FOV: 45 degrees; 1725 by 1721 pixels; color fundus photograph
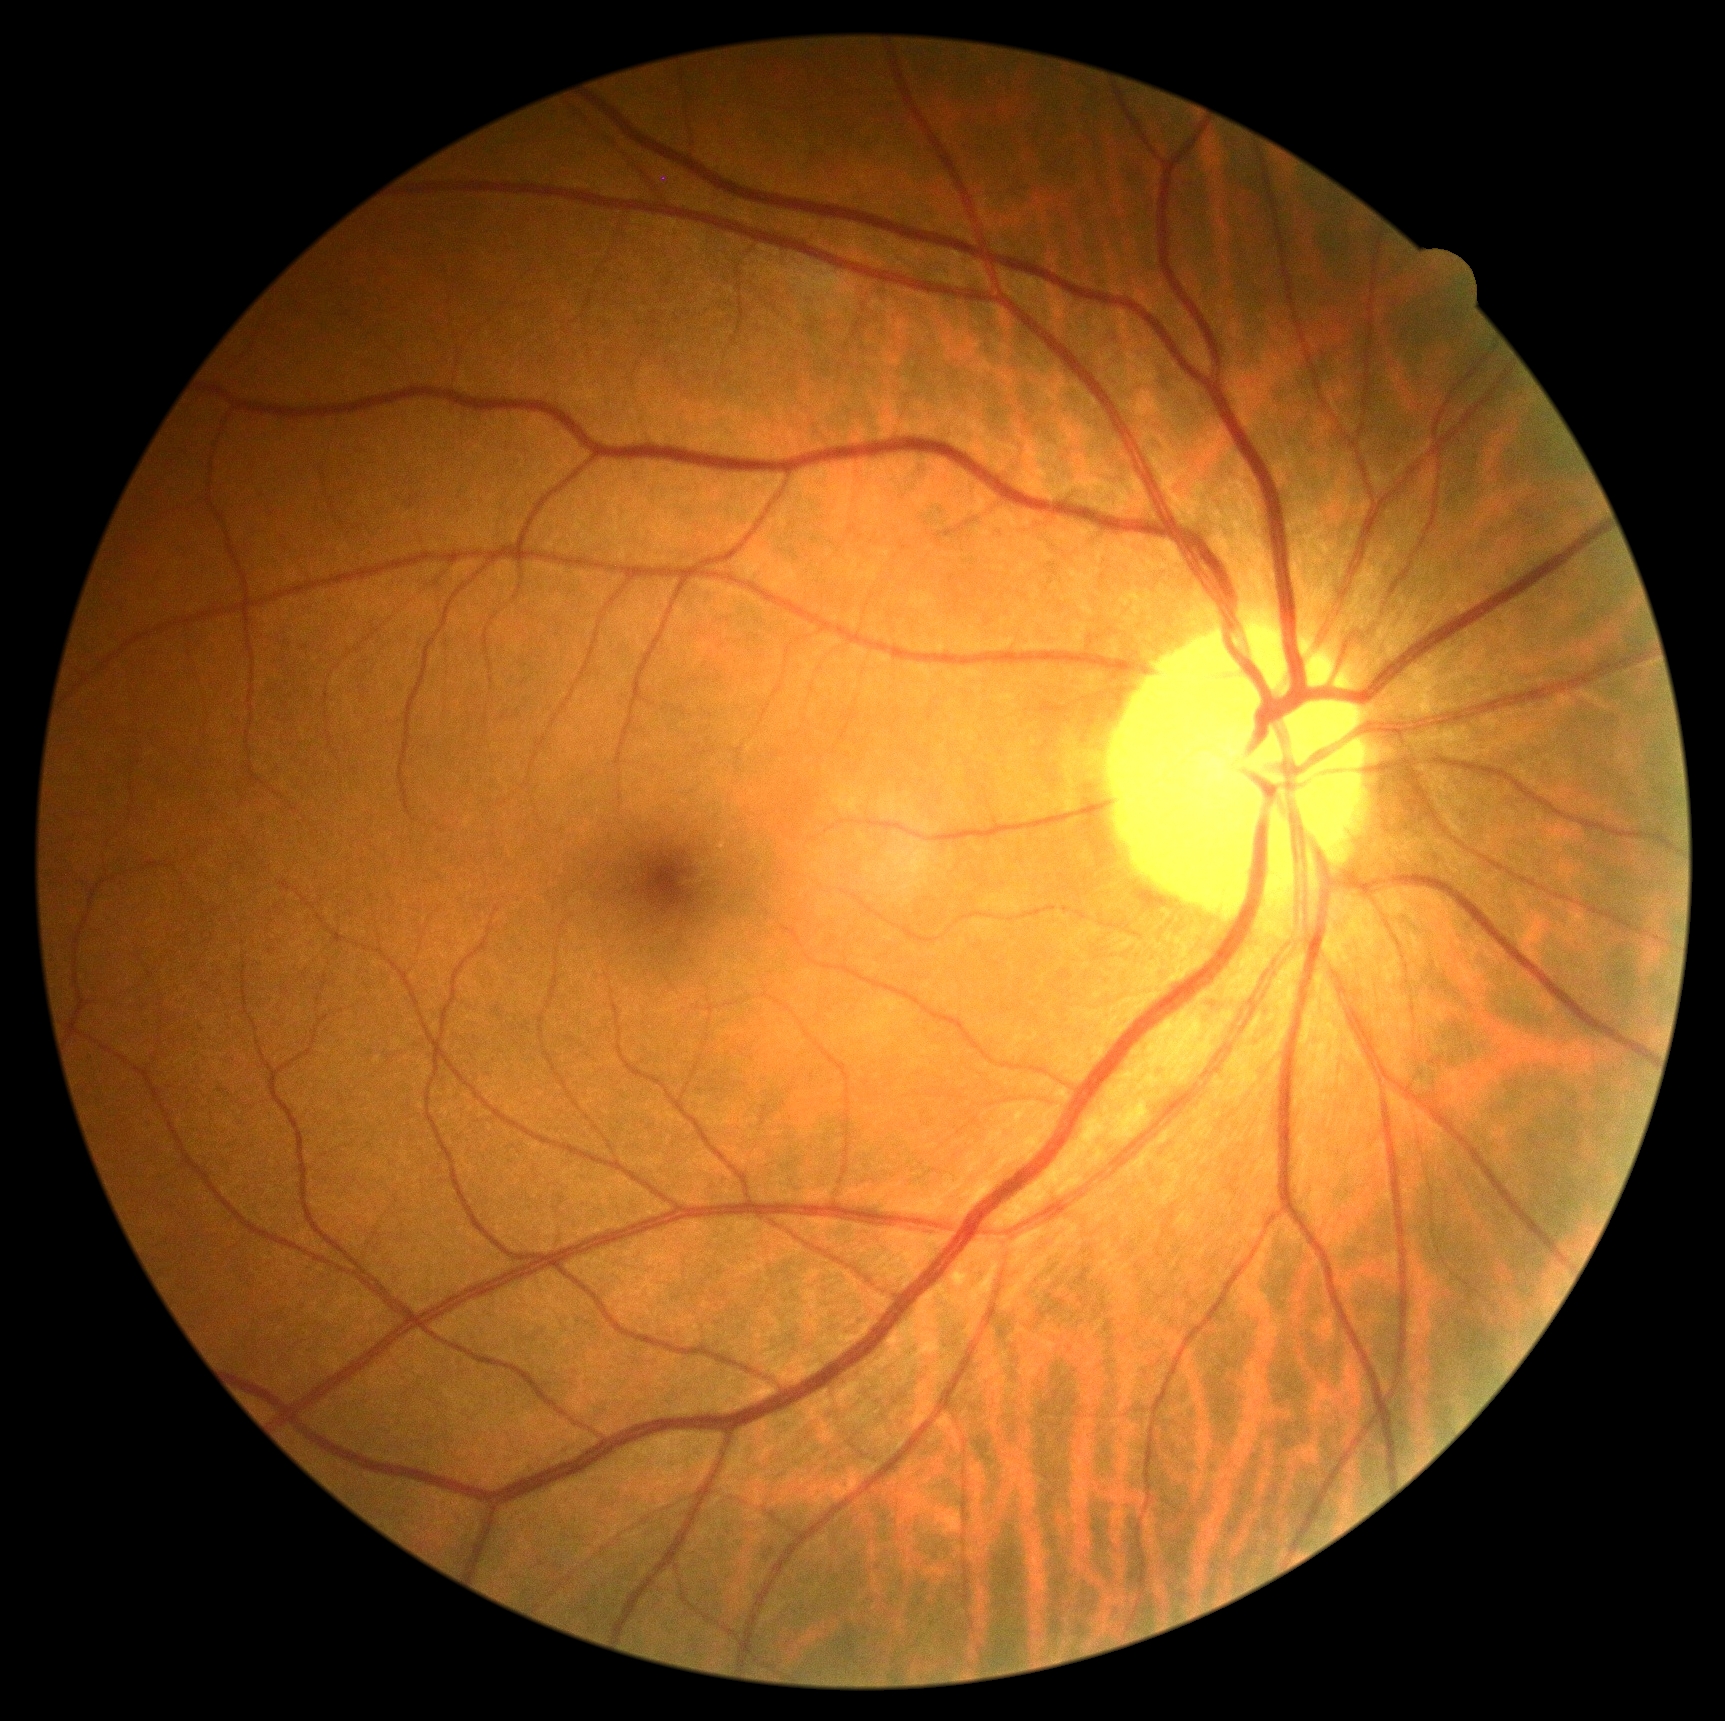
Findings:
- diabetic retinopathy: no apparent diabetic retinopathy (grade 0)